45 degree fundus photograph, no pharmacologic dilation:
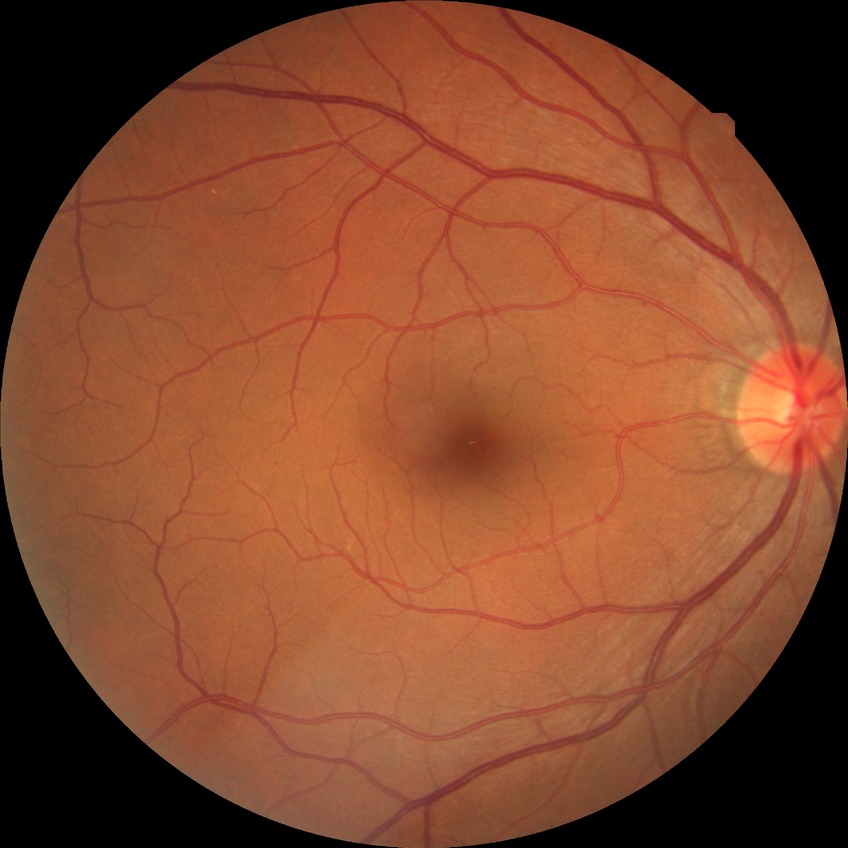
diabetic retinopathy (DR): no diabetic retinopathy (NDR).